Without pupil dilation; 45-degree field of view; modified Davis grading; CFP; NIDEK AFC-230: 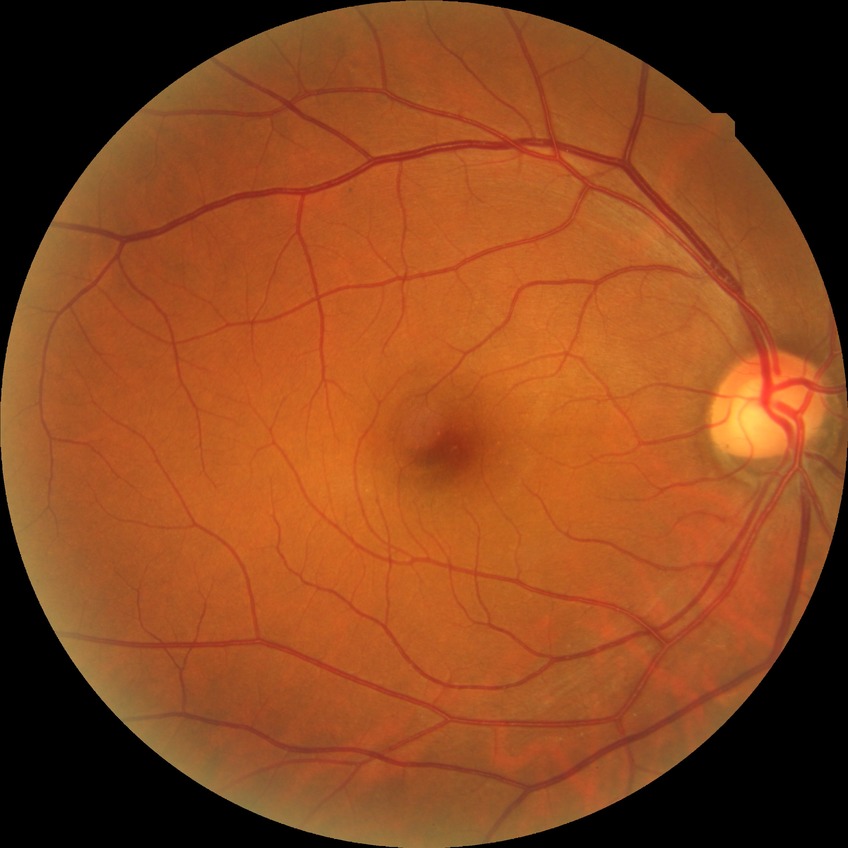
DR grade is NDR. No apparent diabetic retinopathy.